2352 x 1568 pixels.
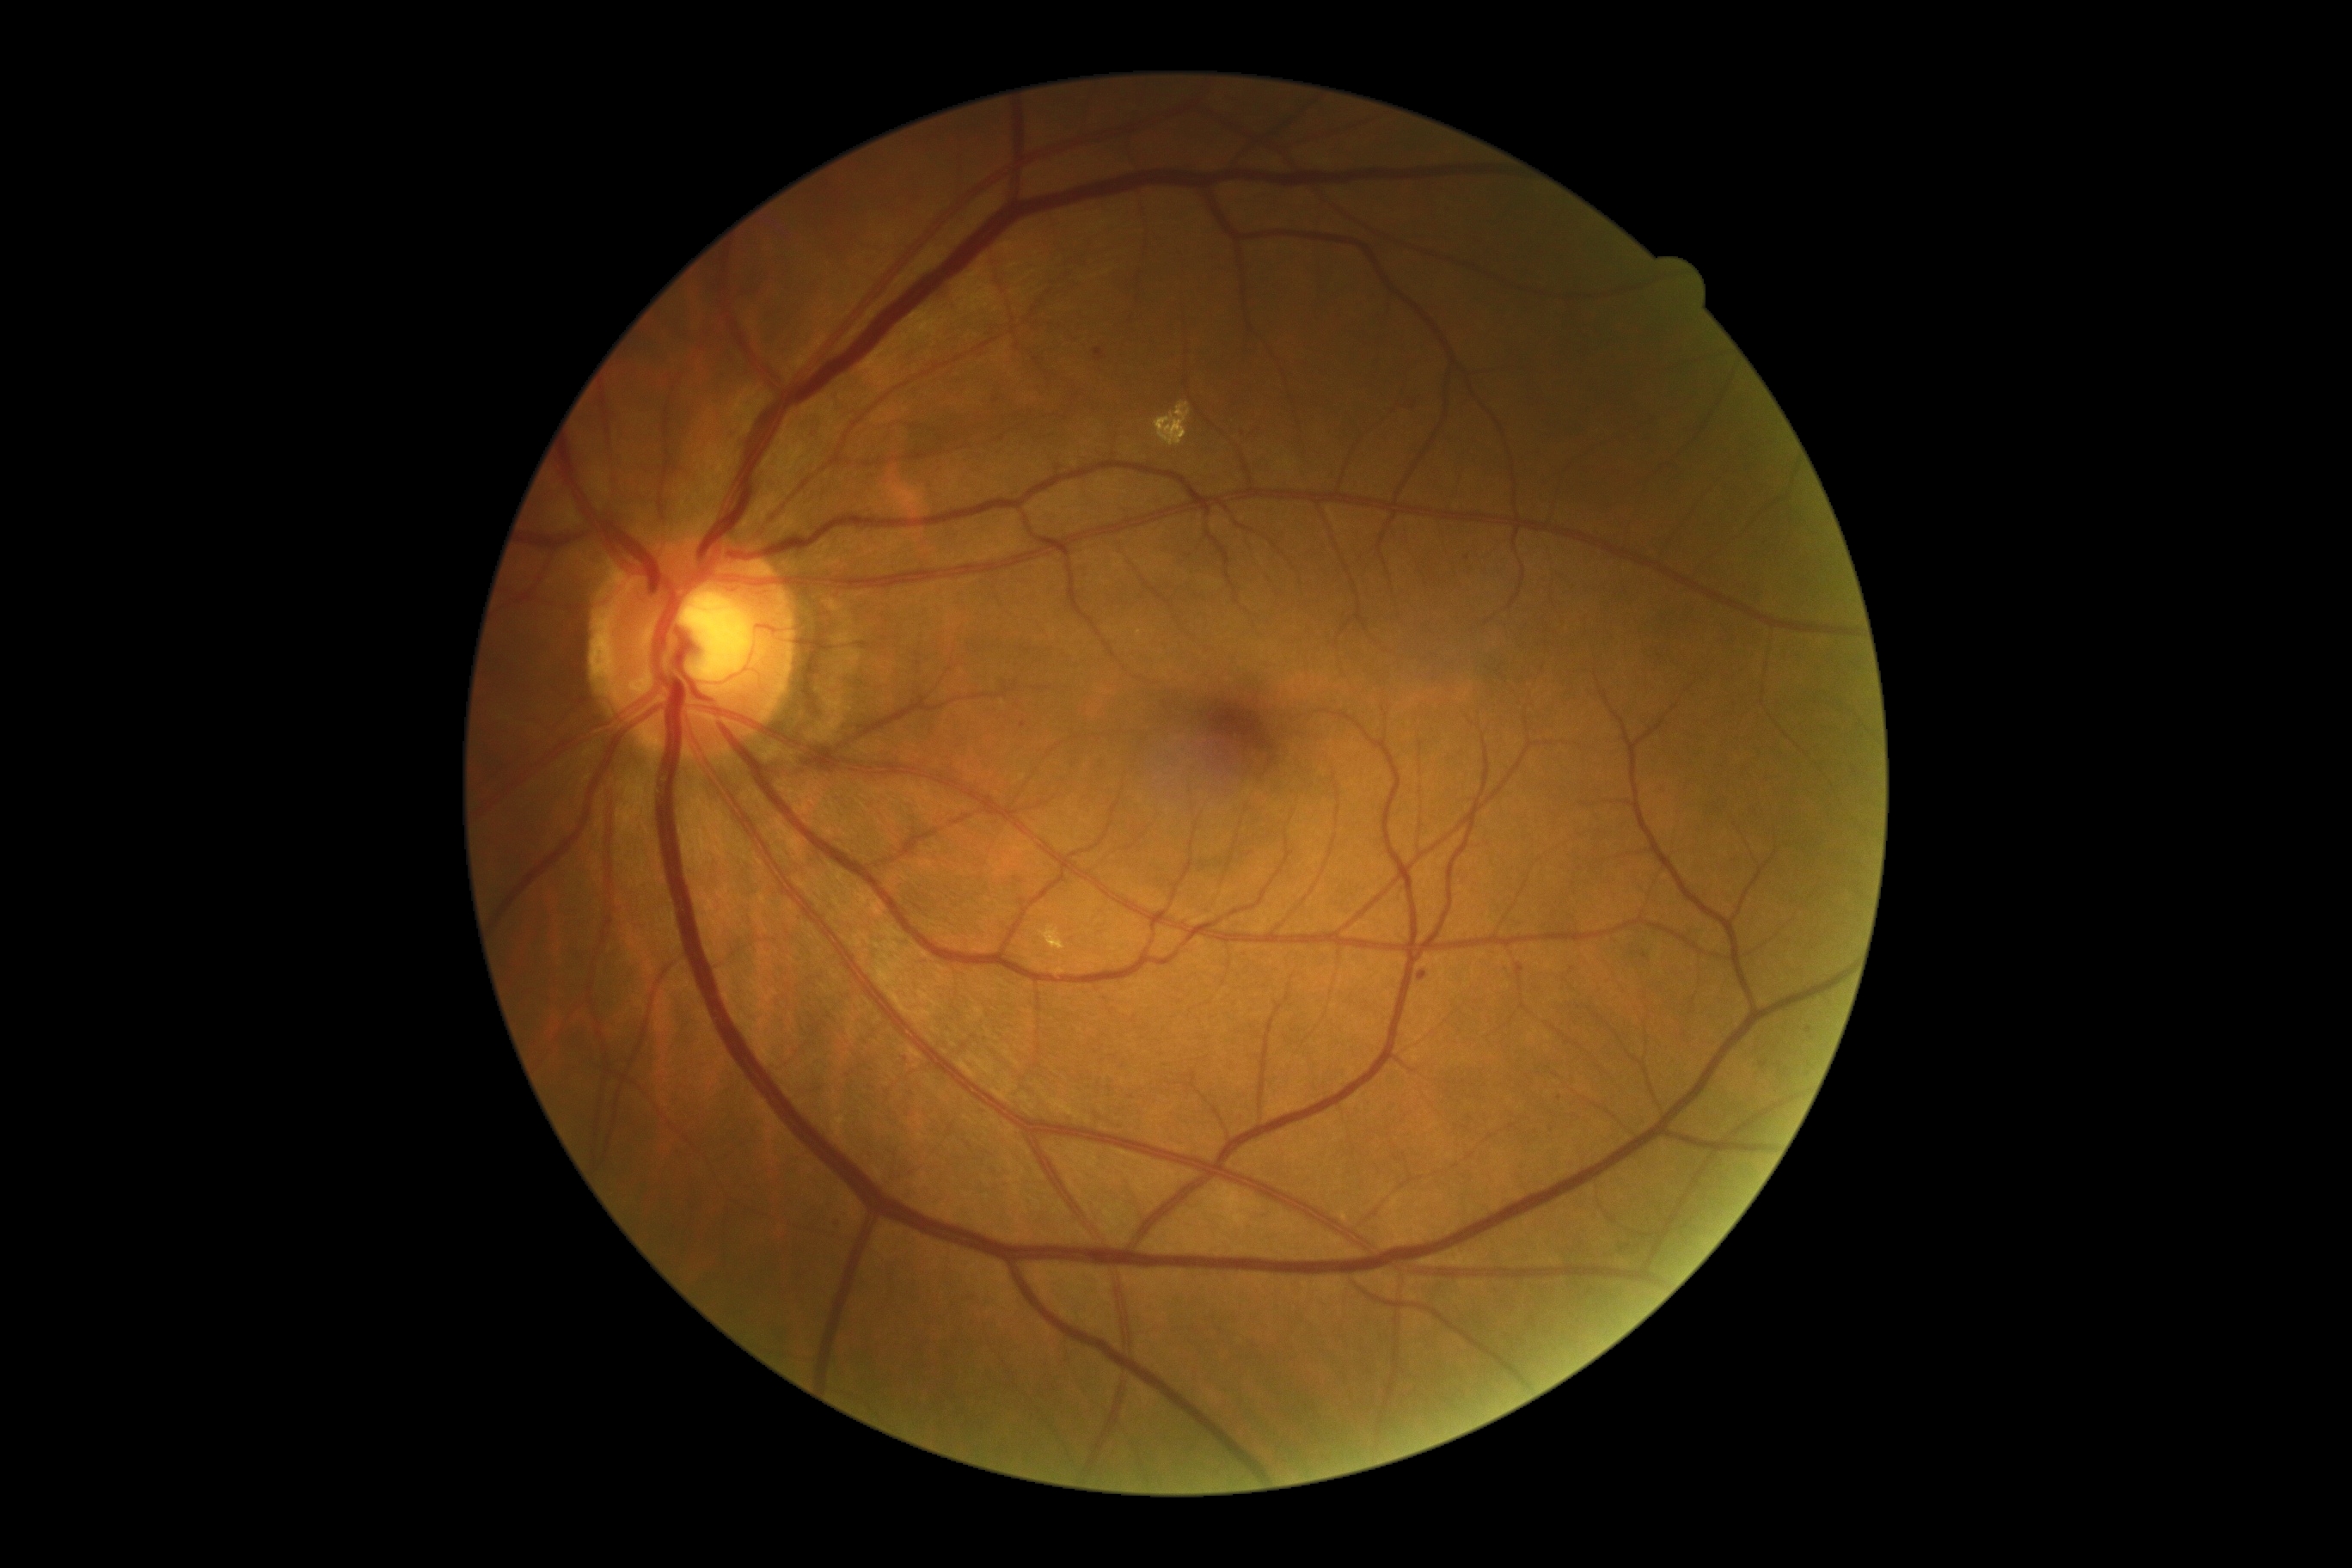
DR stage is 2.
No SEs identified.
MAs (partial list) at bbox=(1418, 972, 1428, 983), bbox=(1094, 348, 1106, 362).
MAs (small, approximate centers) near <pt>1023,726</pt>, <pt>1763,1065</pt>, <pt>1467,559</pt>, <pt>838,1223</pt>, <pt>1059,469</pt>, <pt>1810,1029</pt>, <pt>1572,970</pt>, <pt>1522,968</pt>, <pt>1559,1098</pt>.
EXs found at bbox=(1039, 926, 1065, 952), bbox=(1155, 401, 1192, 448).
No HEs identified.